FOV: 45 degrees. Image size 1960x1897. Color fundus photograph
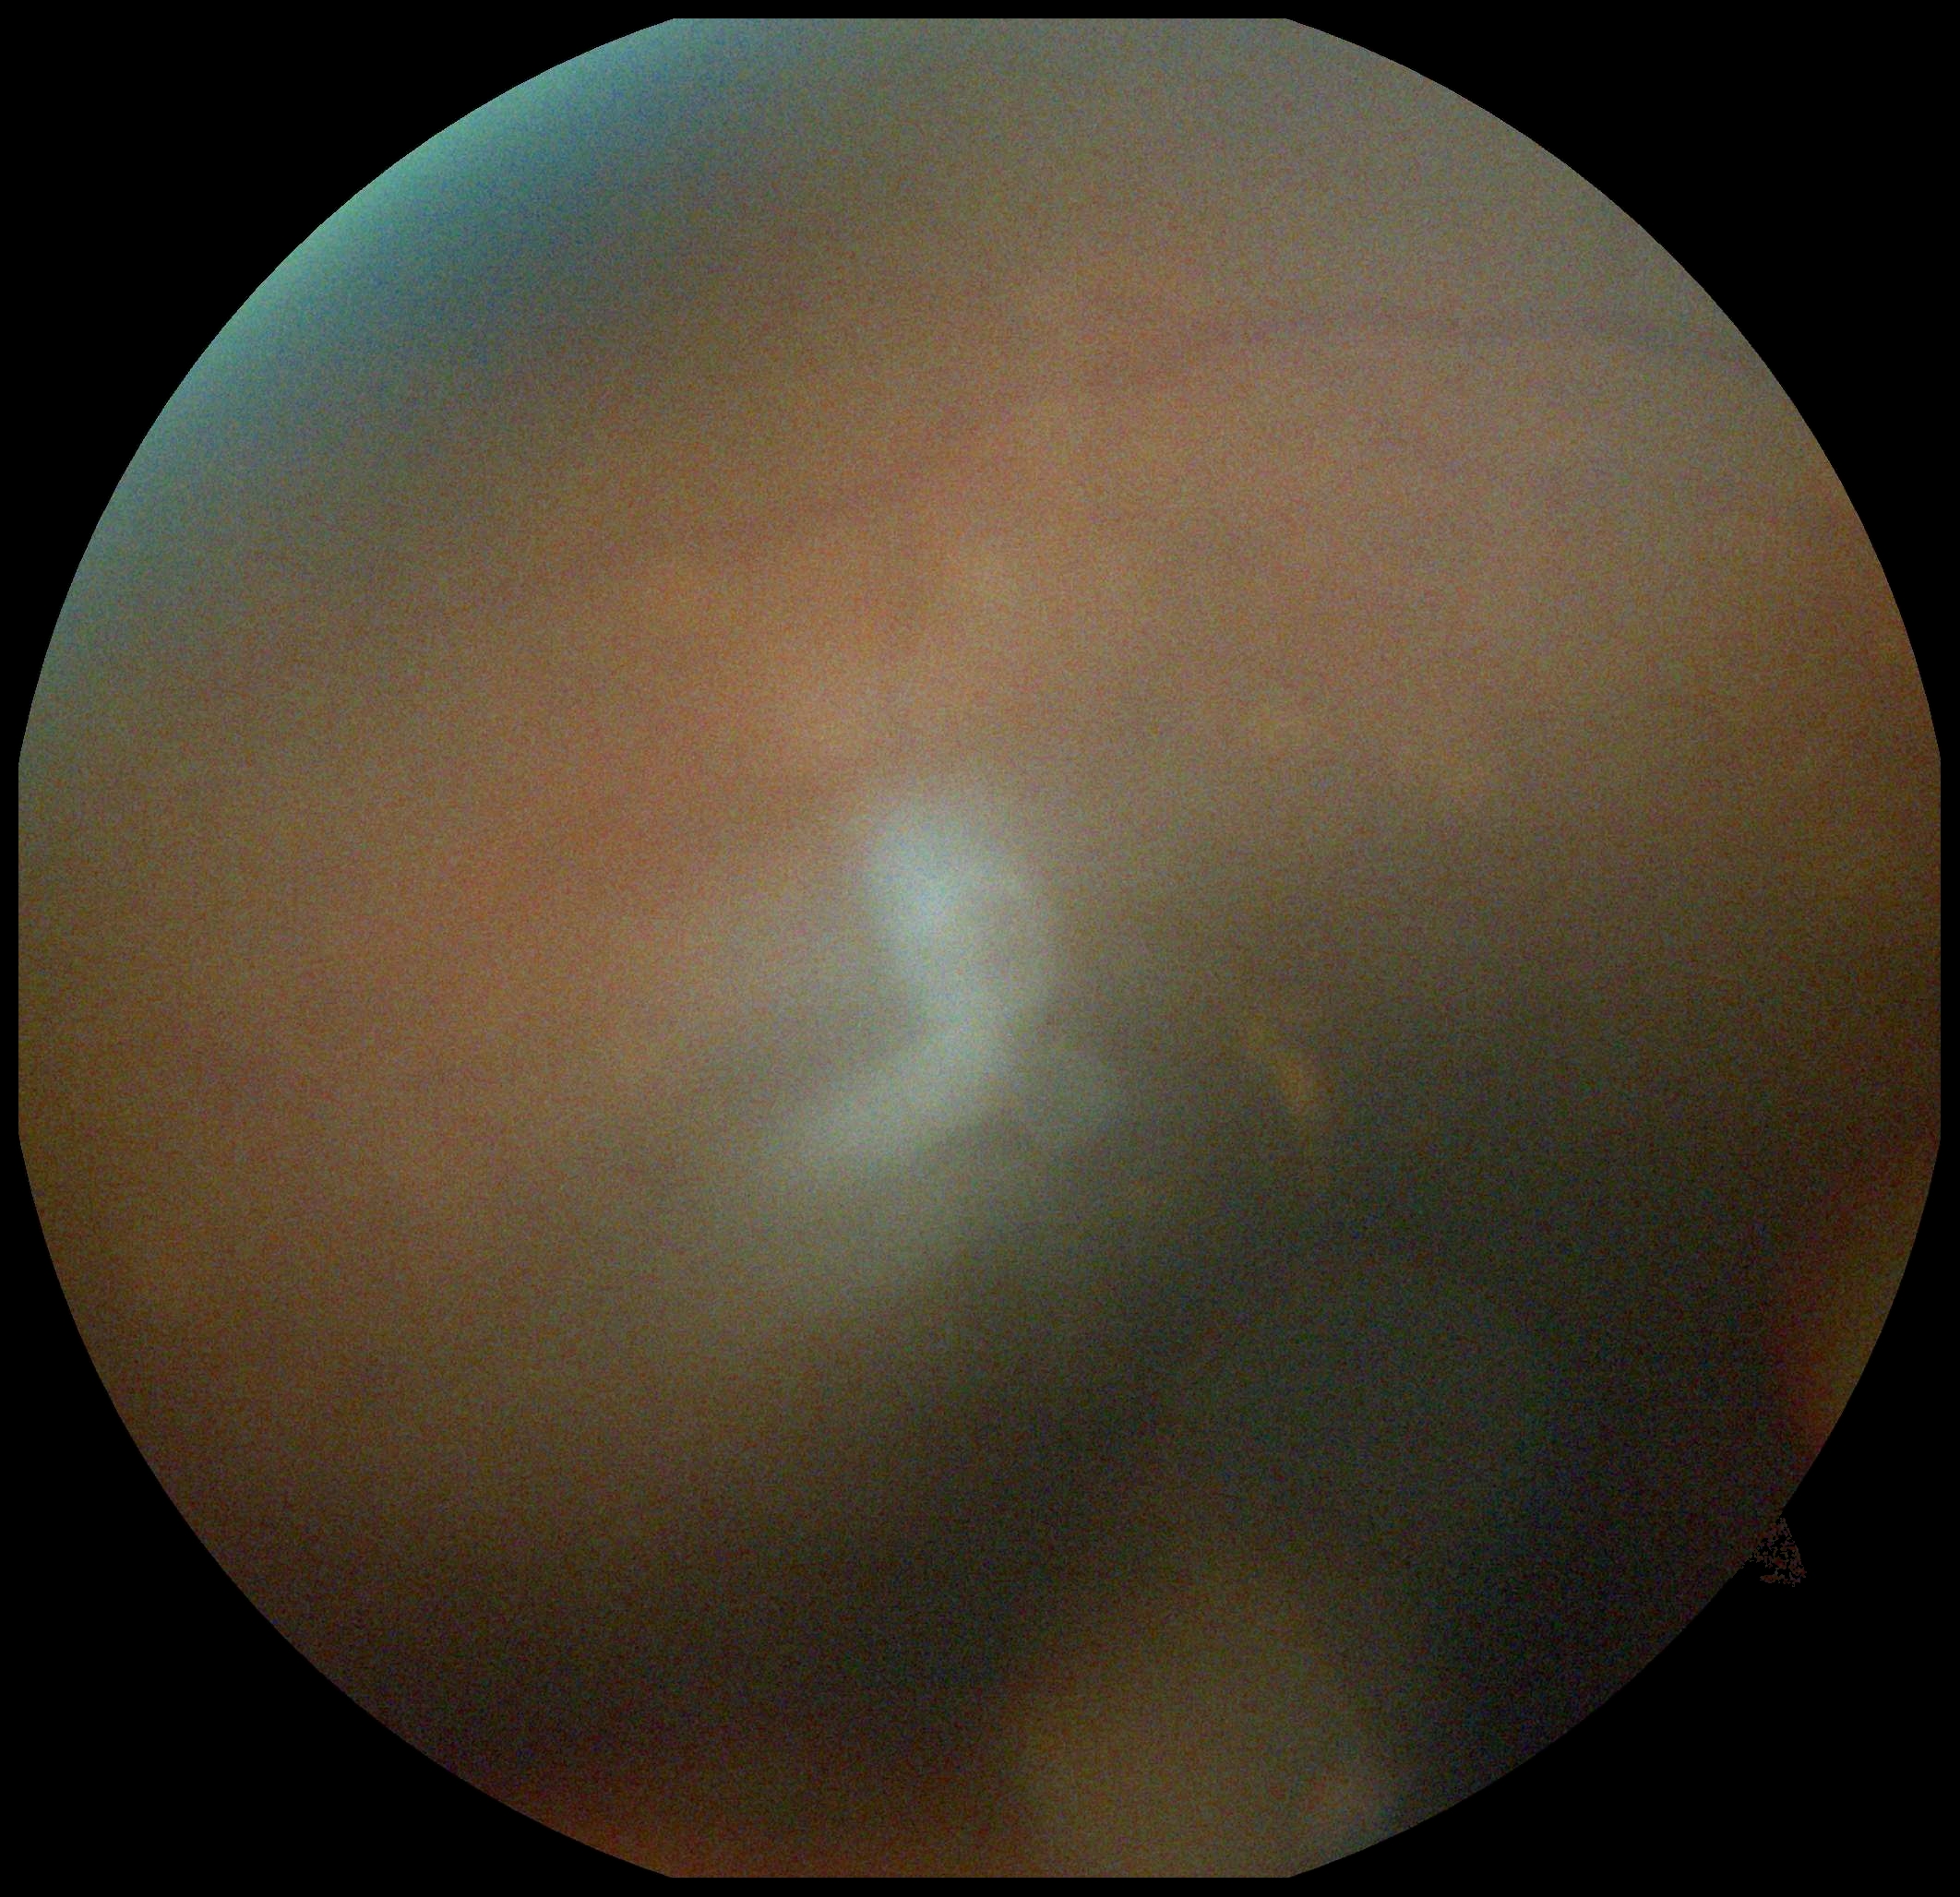

image quality@insufficient for DR assessment; DR grade@ungradable.